No pharmacologic dilation.
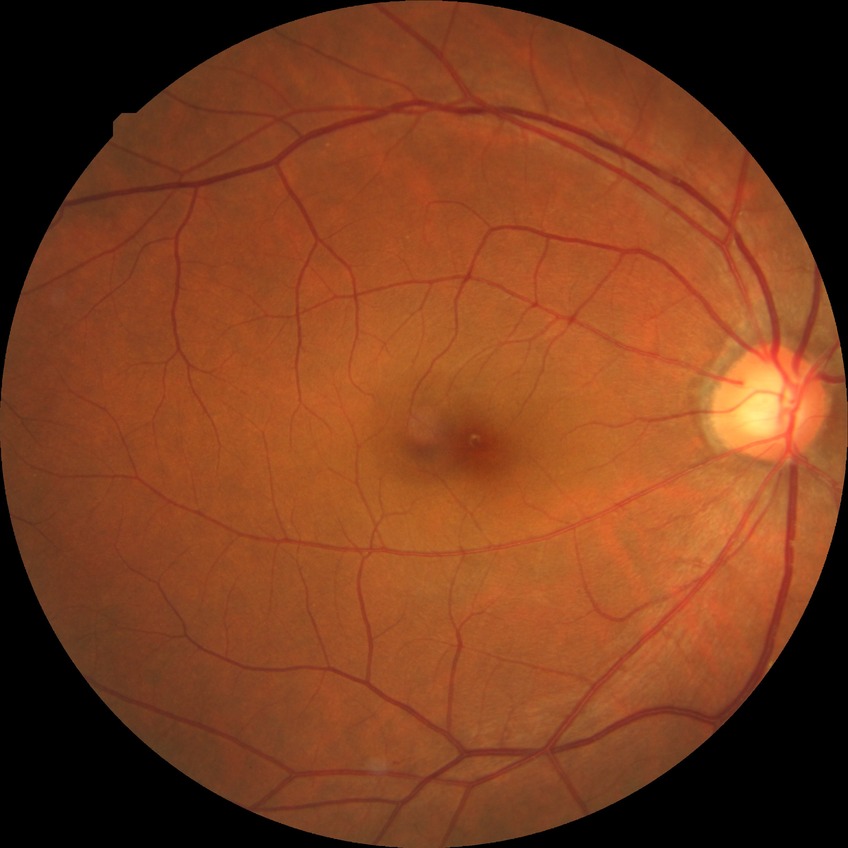
Diabetic retinopathy (DR) is no diabetic retinopathy (NDR).